1932x1932.
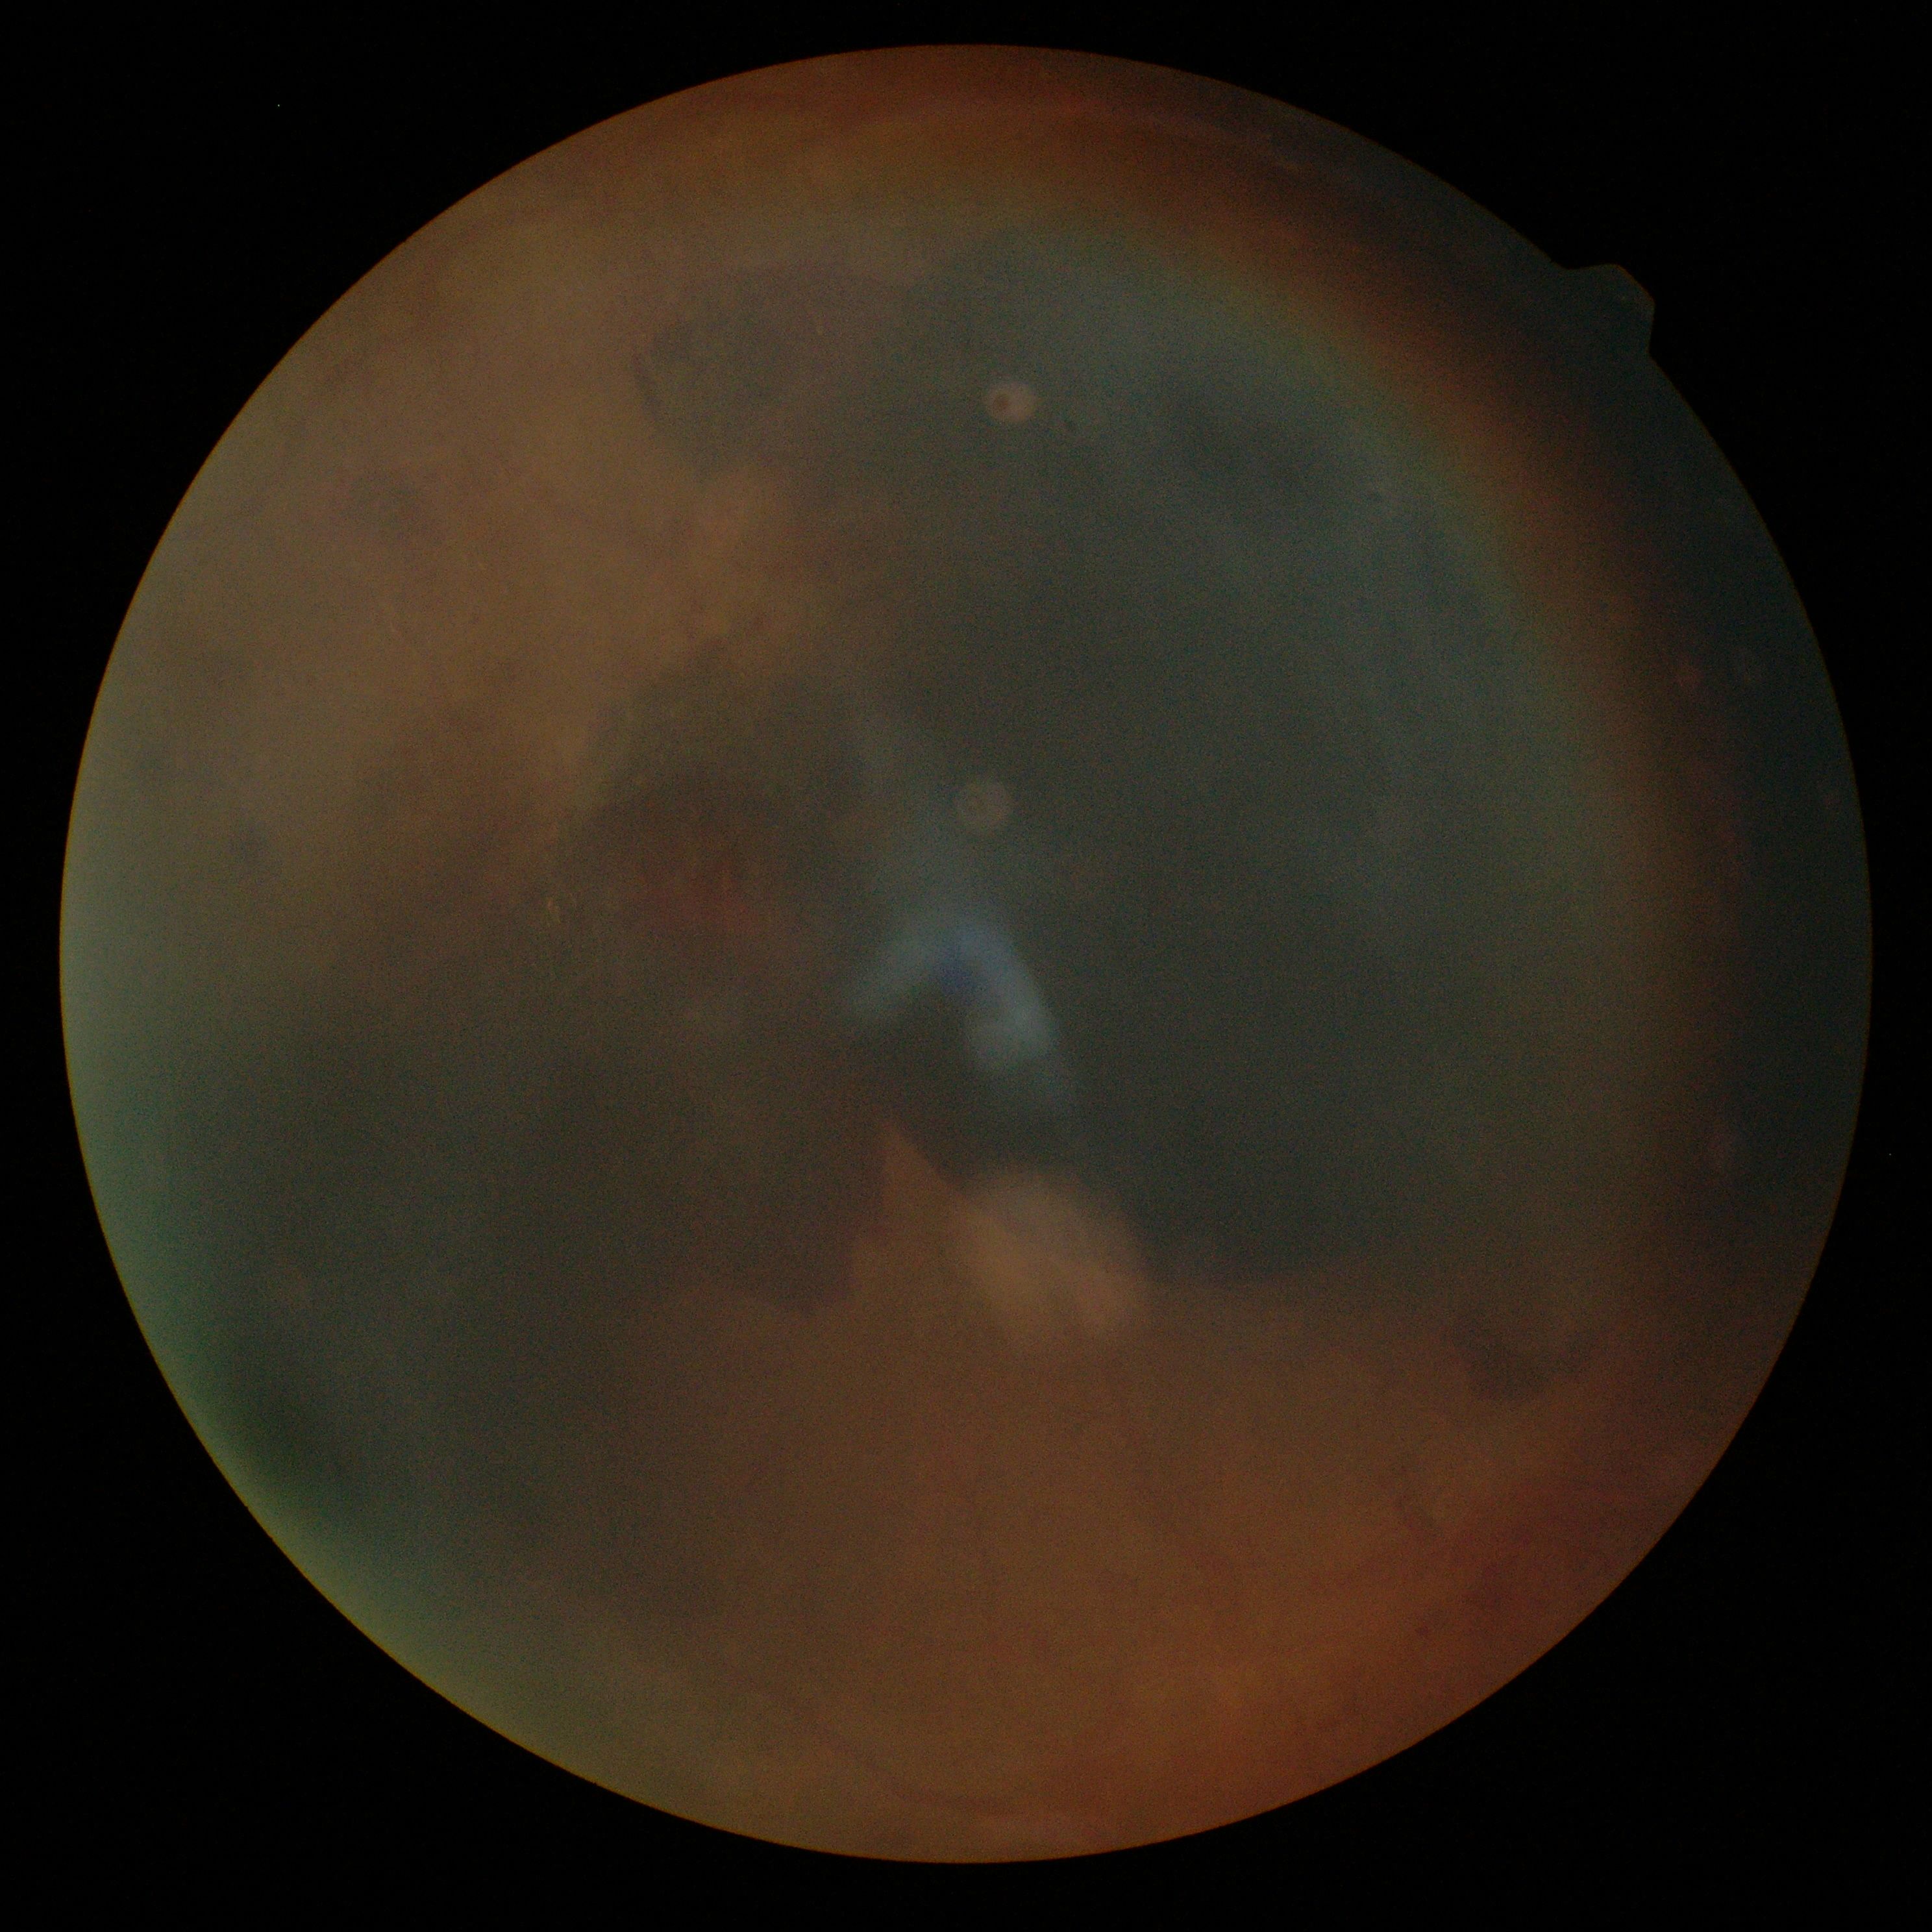

DR class: proliferative diabetic retinopathy.
Diabetic retinopathy: grade 4 (PDR).